Modified Davis classification · 45-degree field of view — 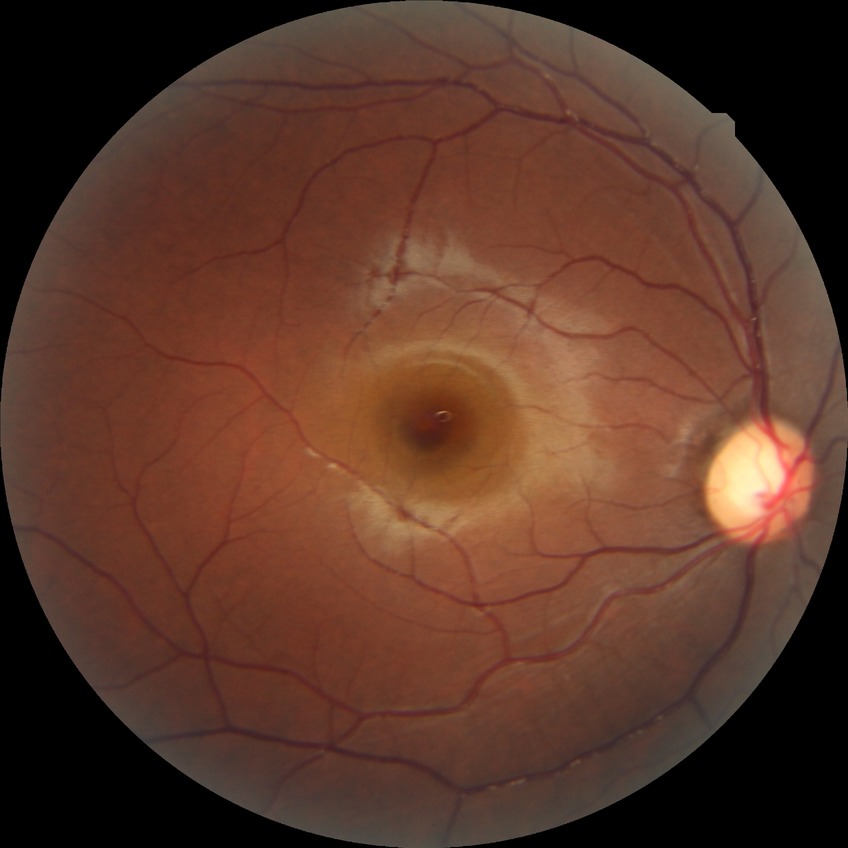
Davis grading is no diabetic retinopathy.